45-degree field of view; 2352 by 1568 pixels; retinal fundus photograph:
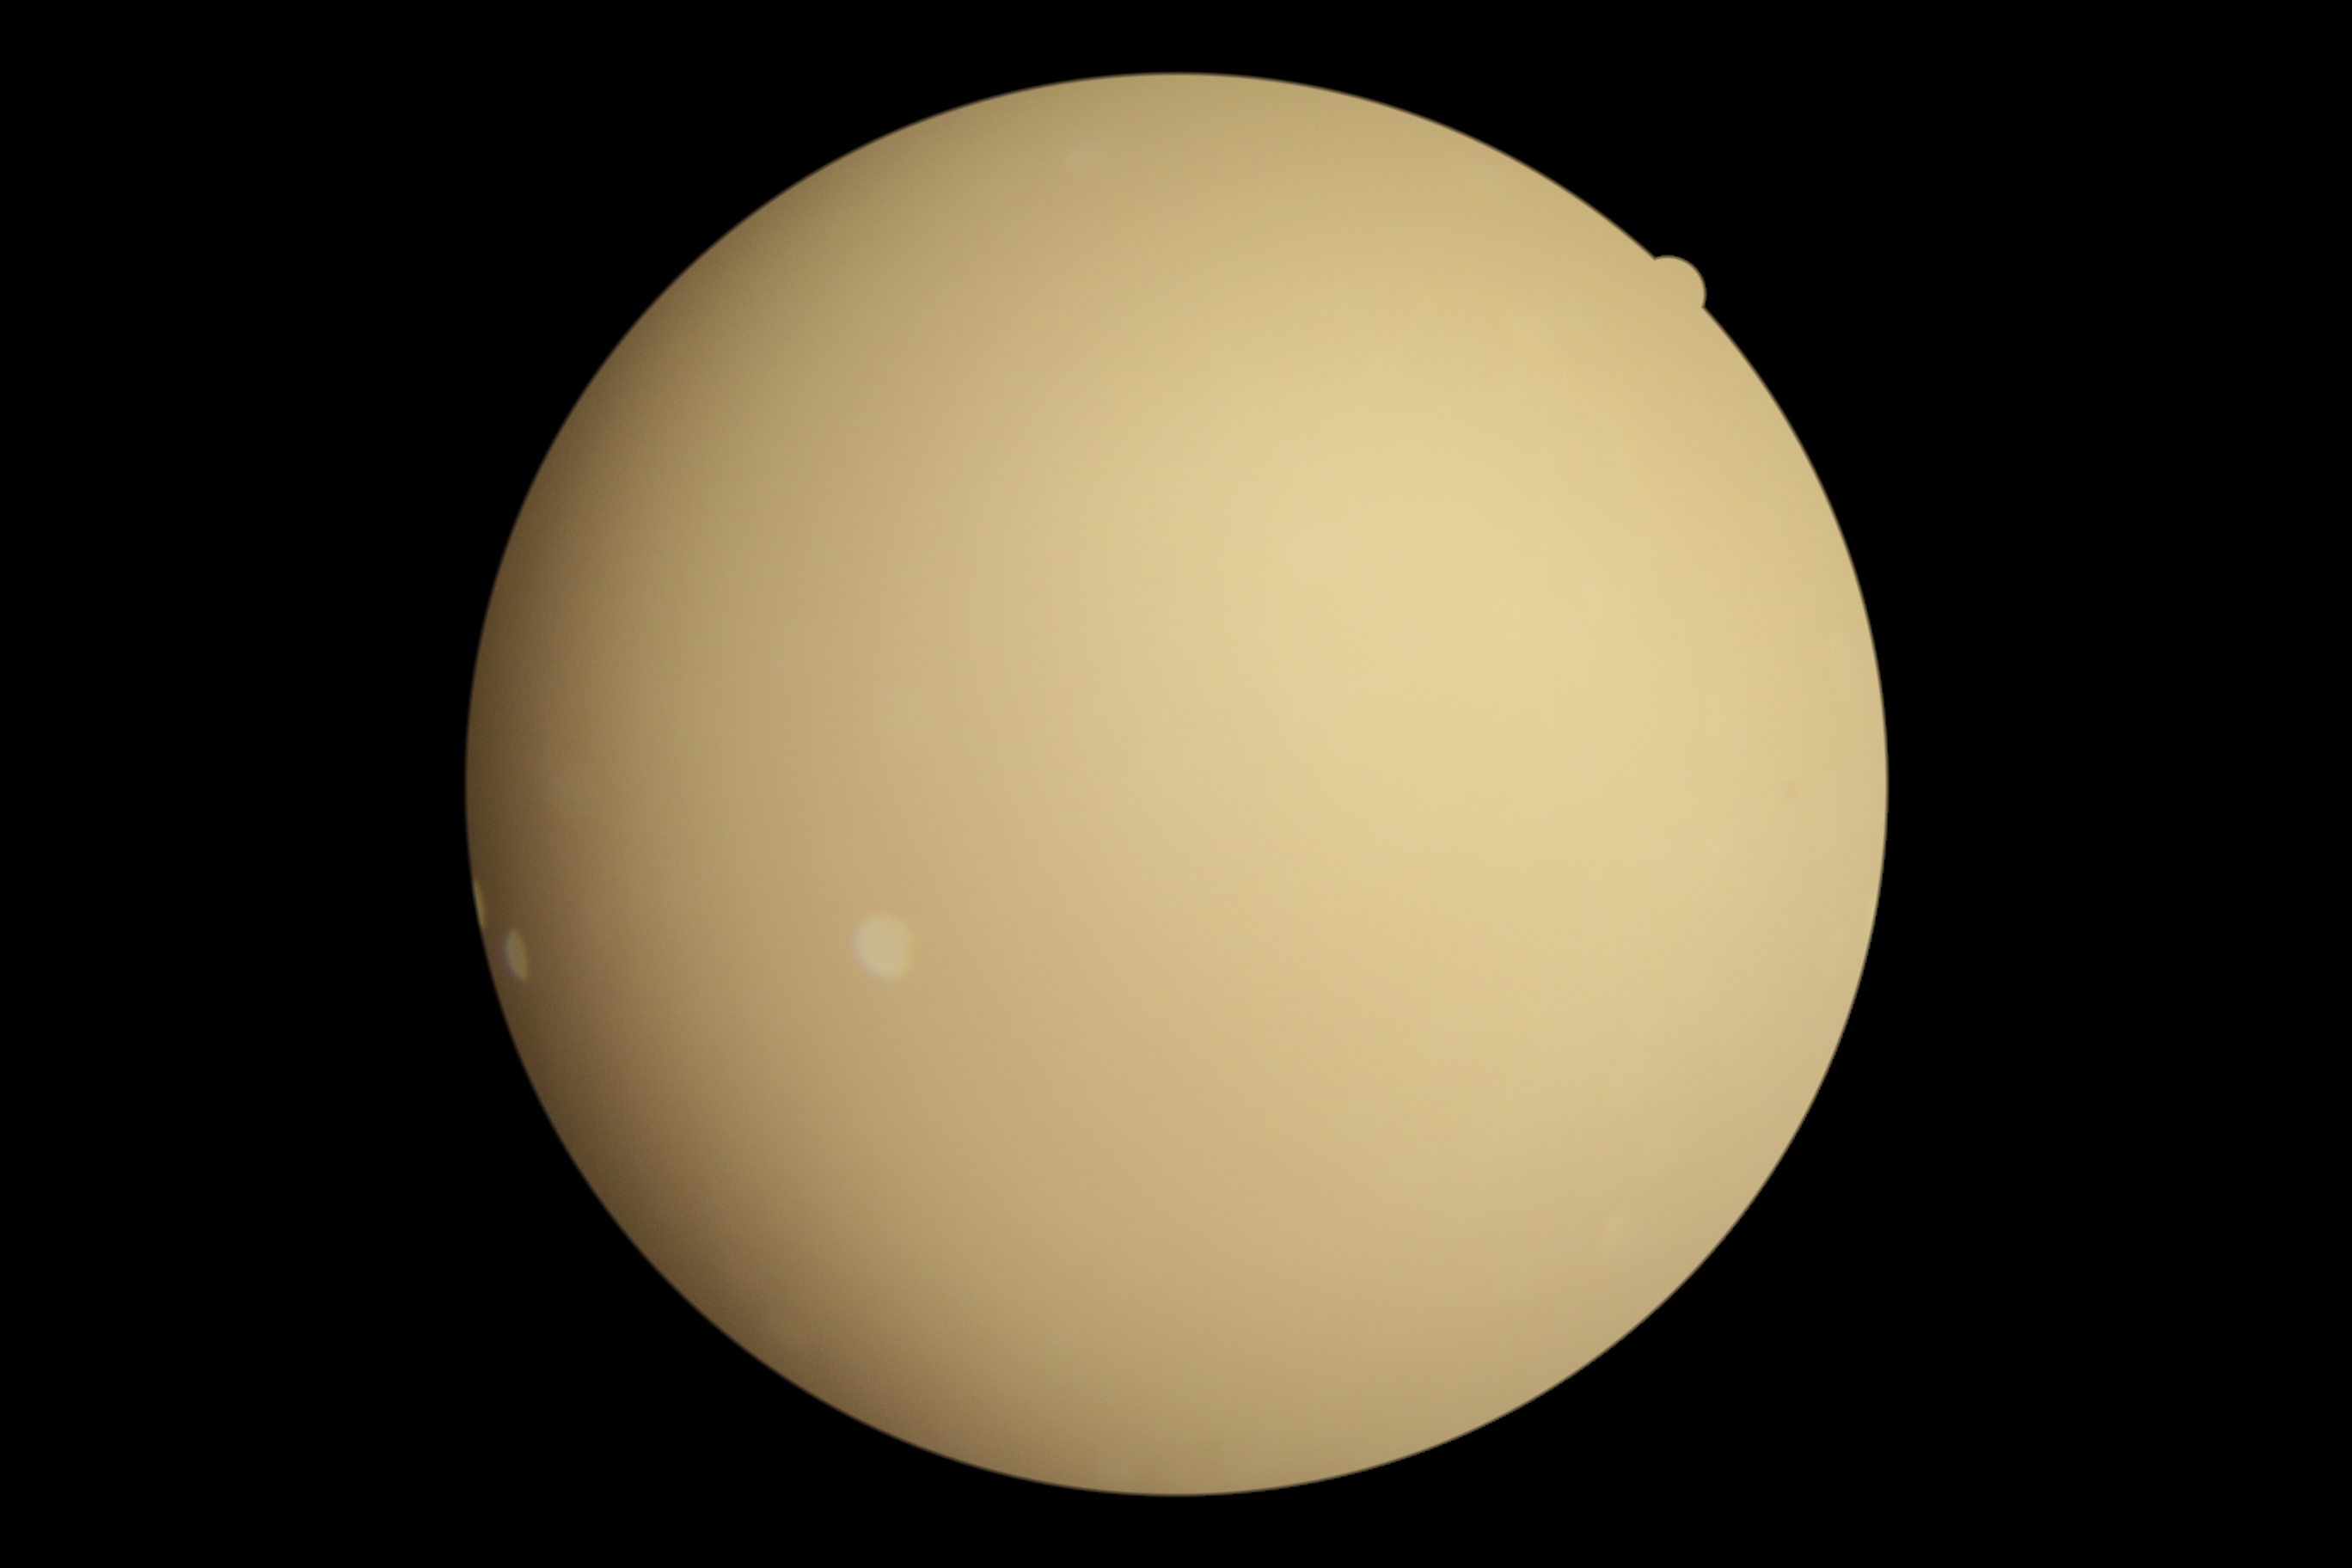

Image quality is insufficient for diabetic retinopathy assessment.
Diabetic retinopathy severity: ungradable due to poor image quality.